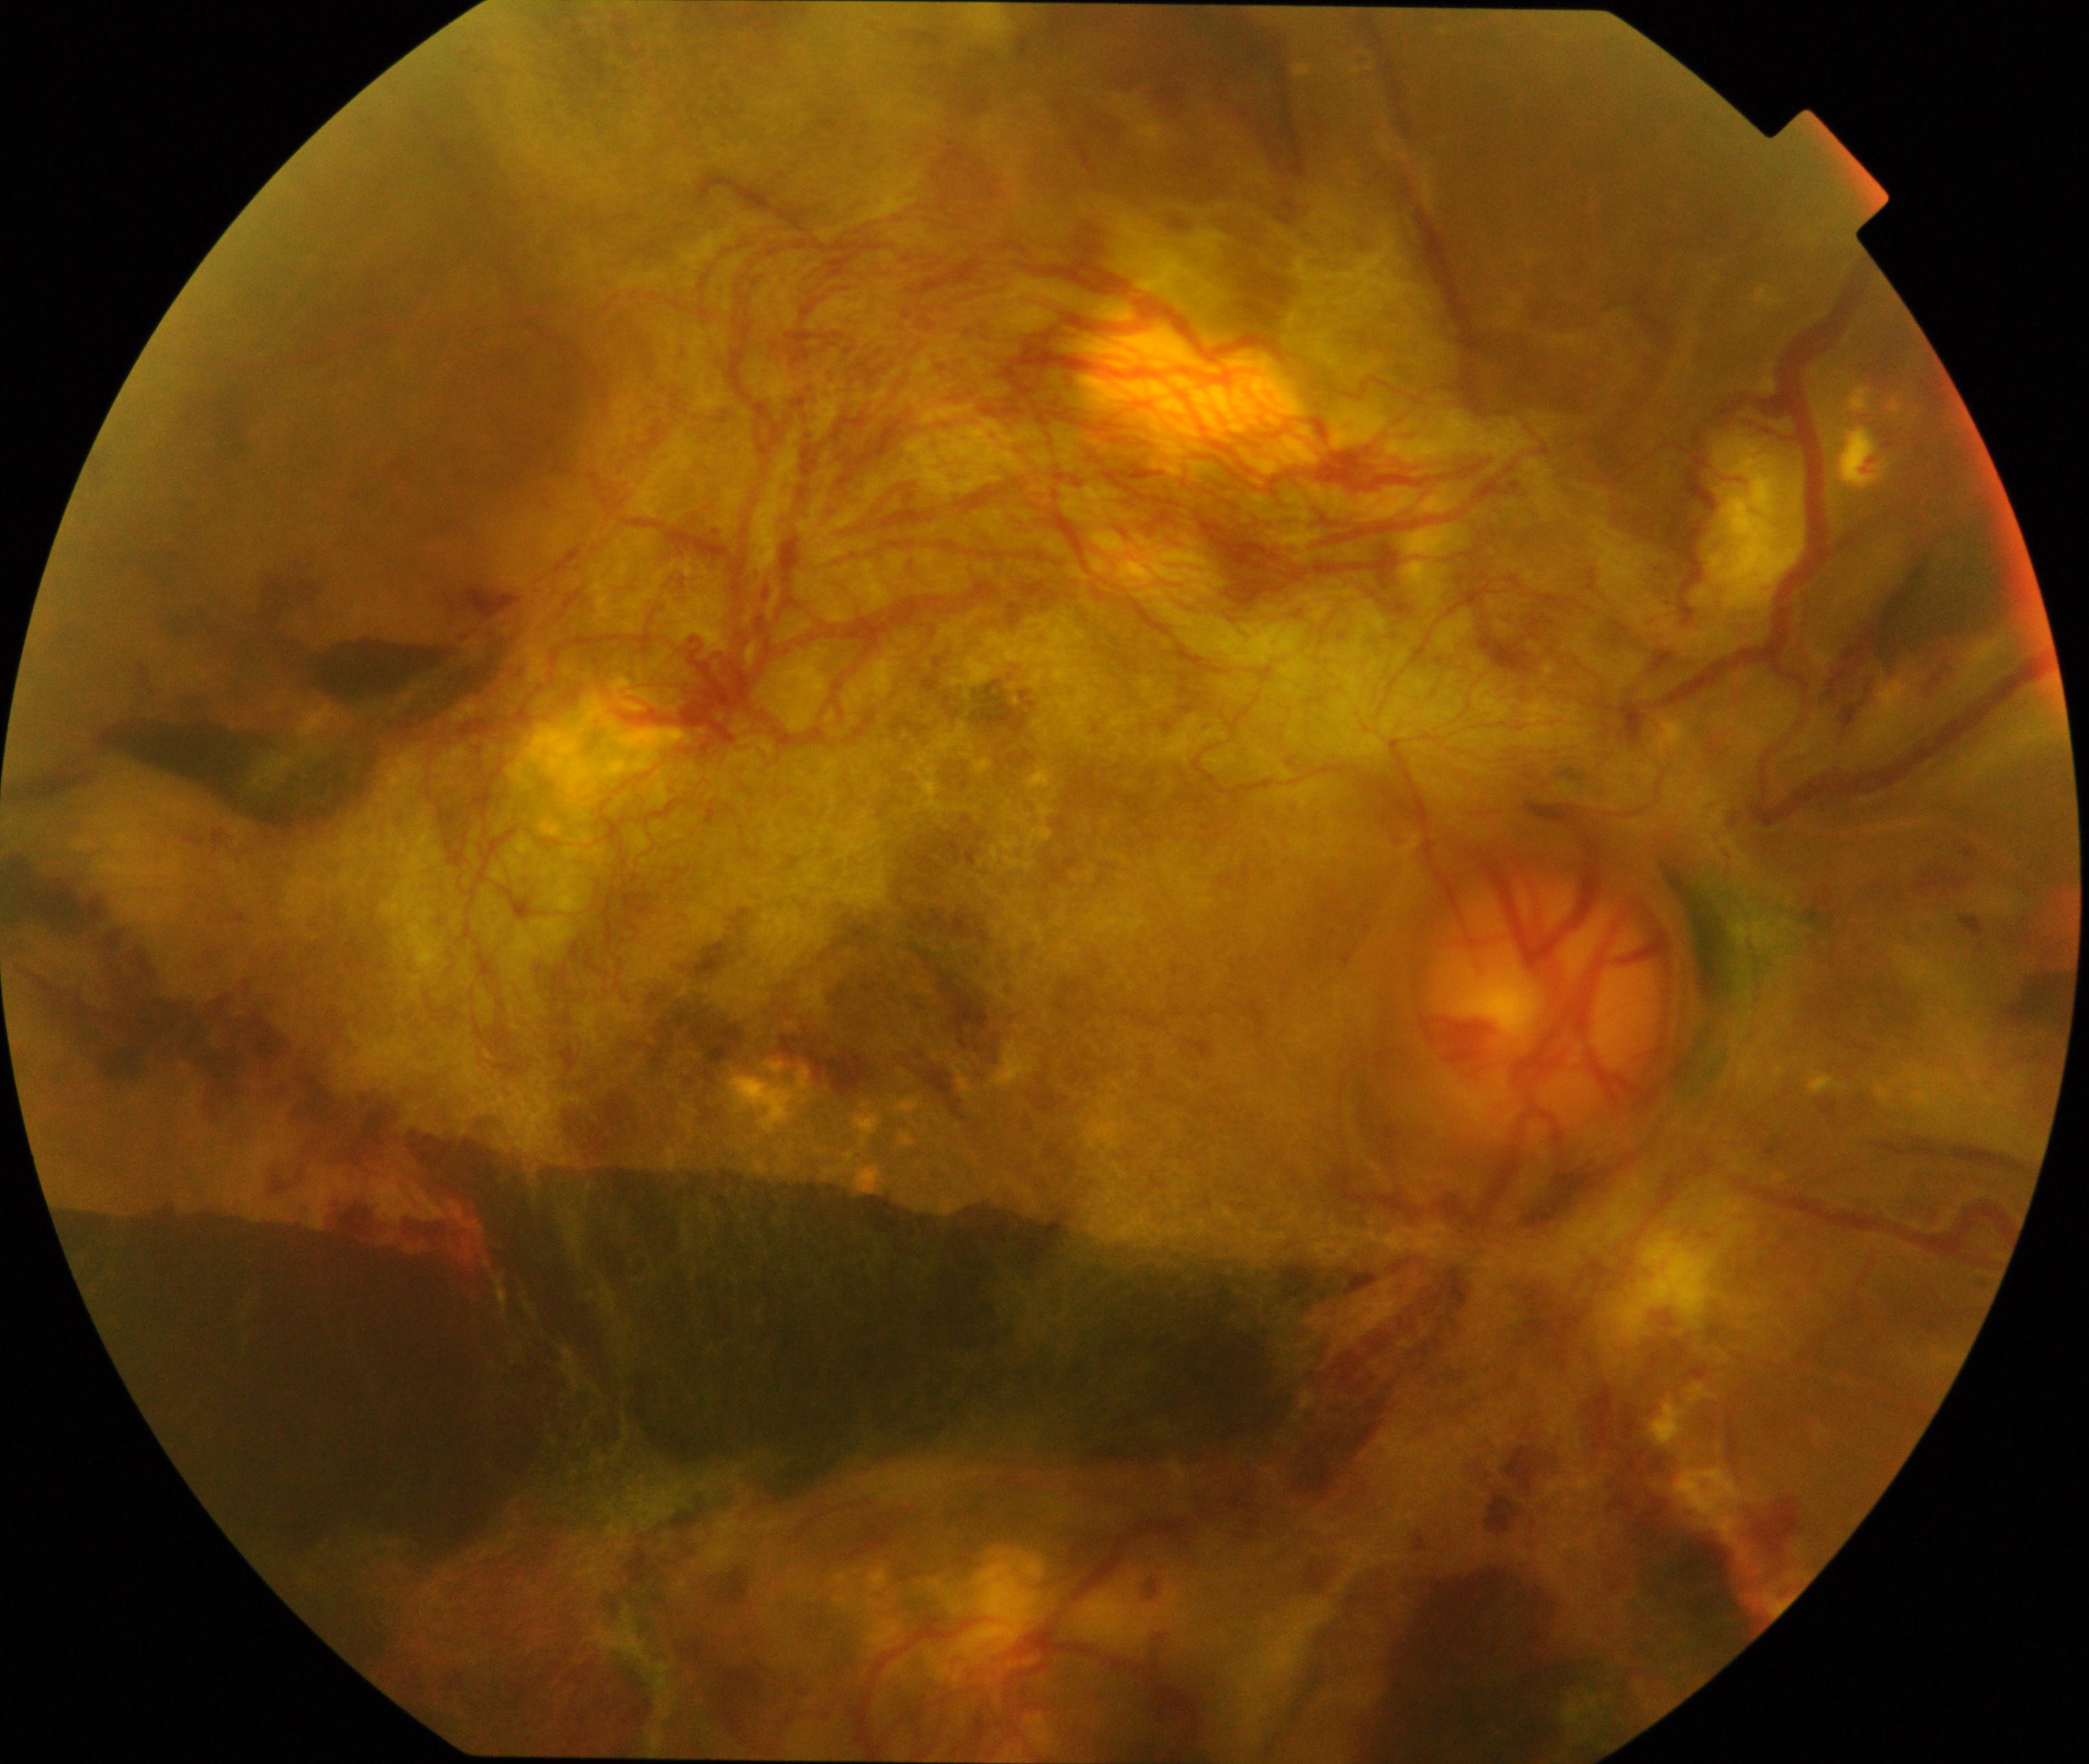

Demonstrates severe non-proliferative or proliferative diabetic retinopathy.